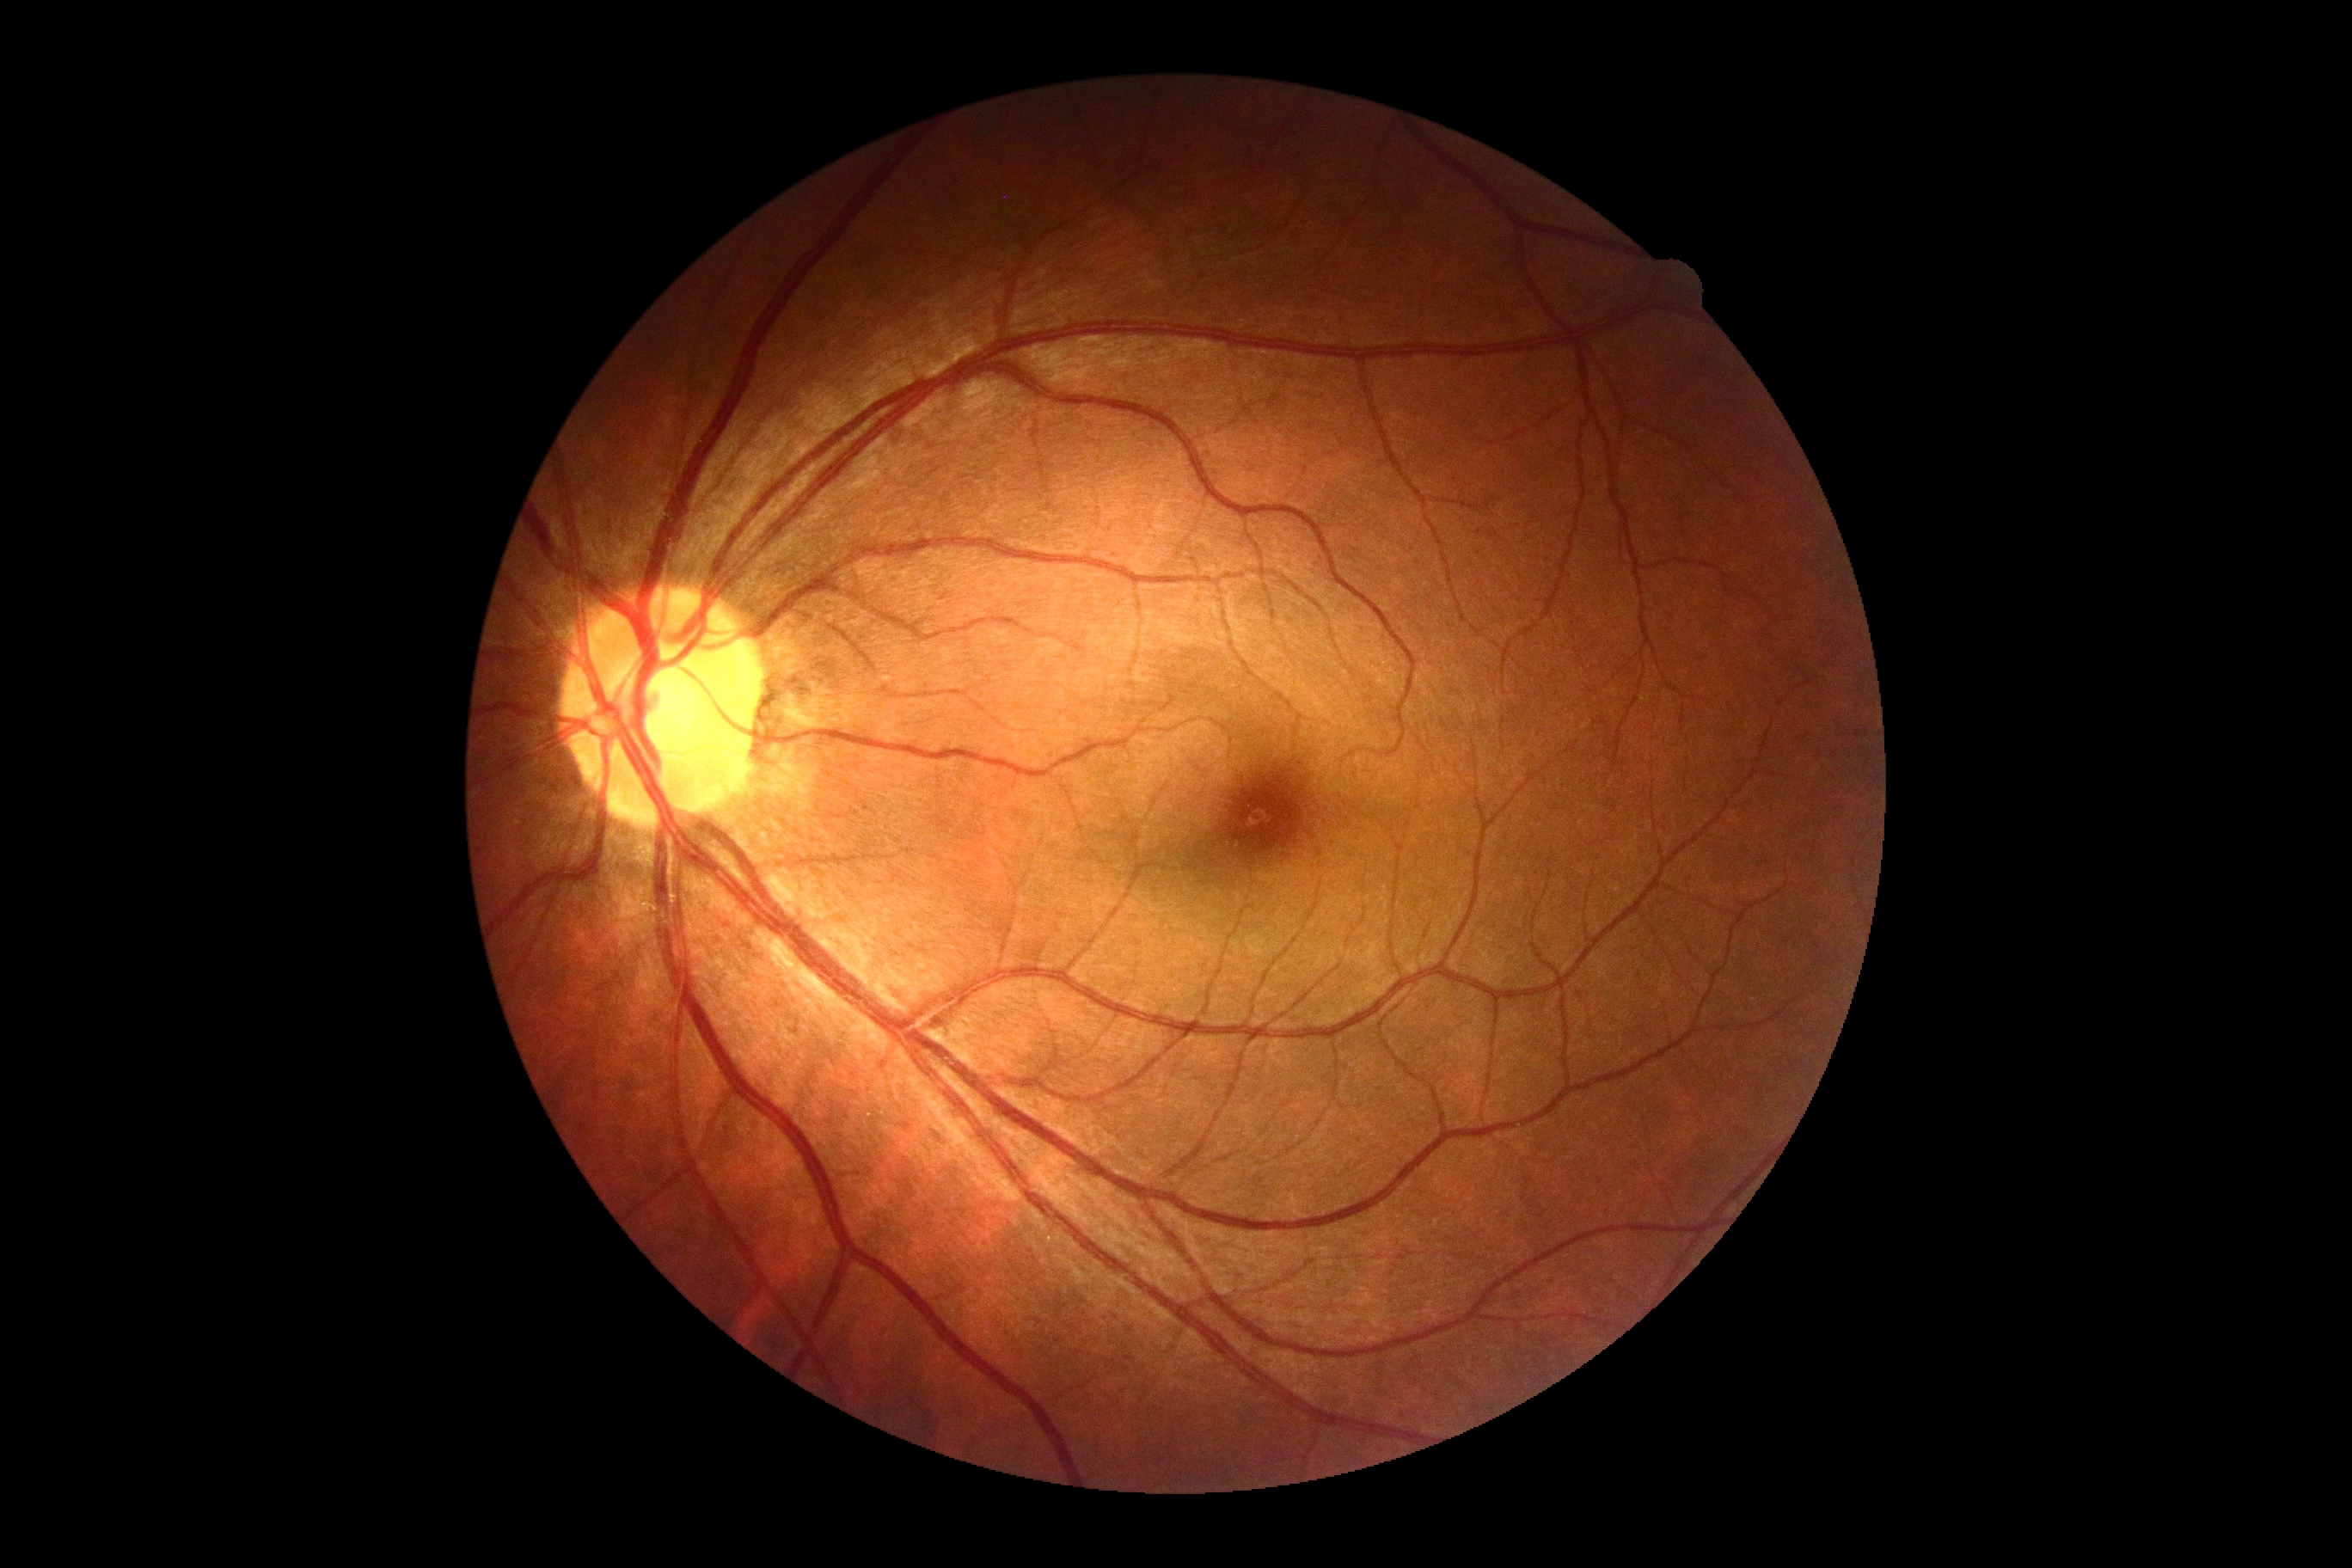

DR impression@no DR findings, DR grade@0.